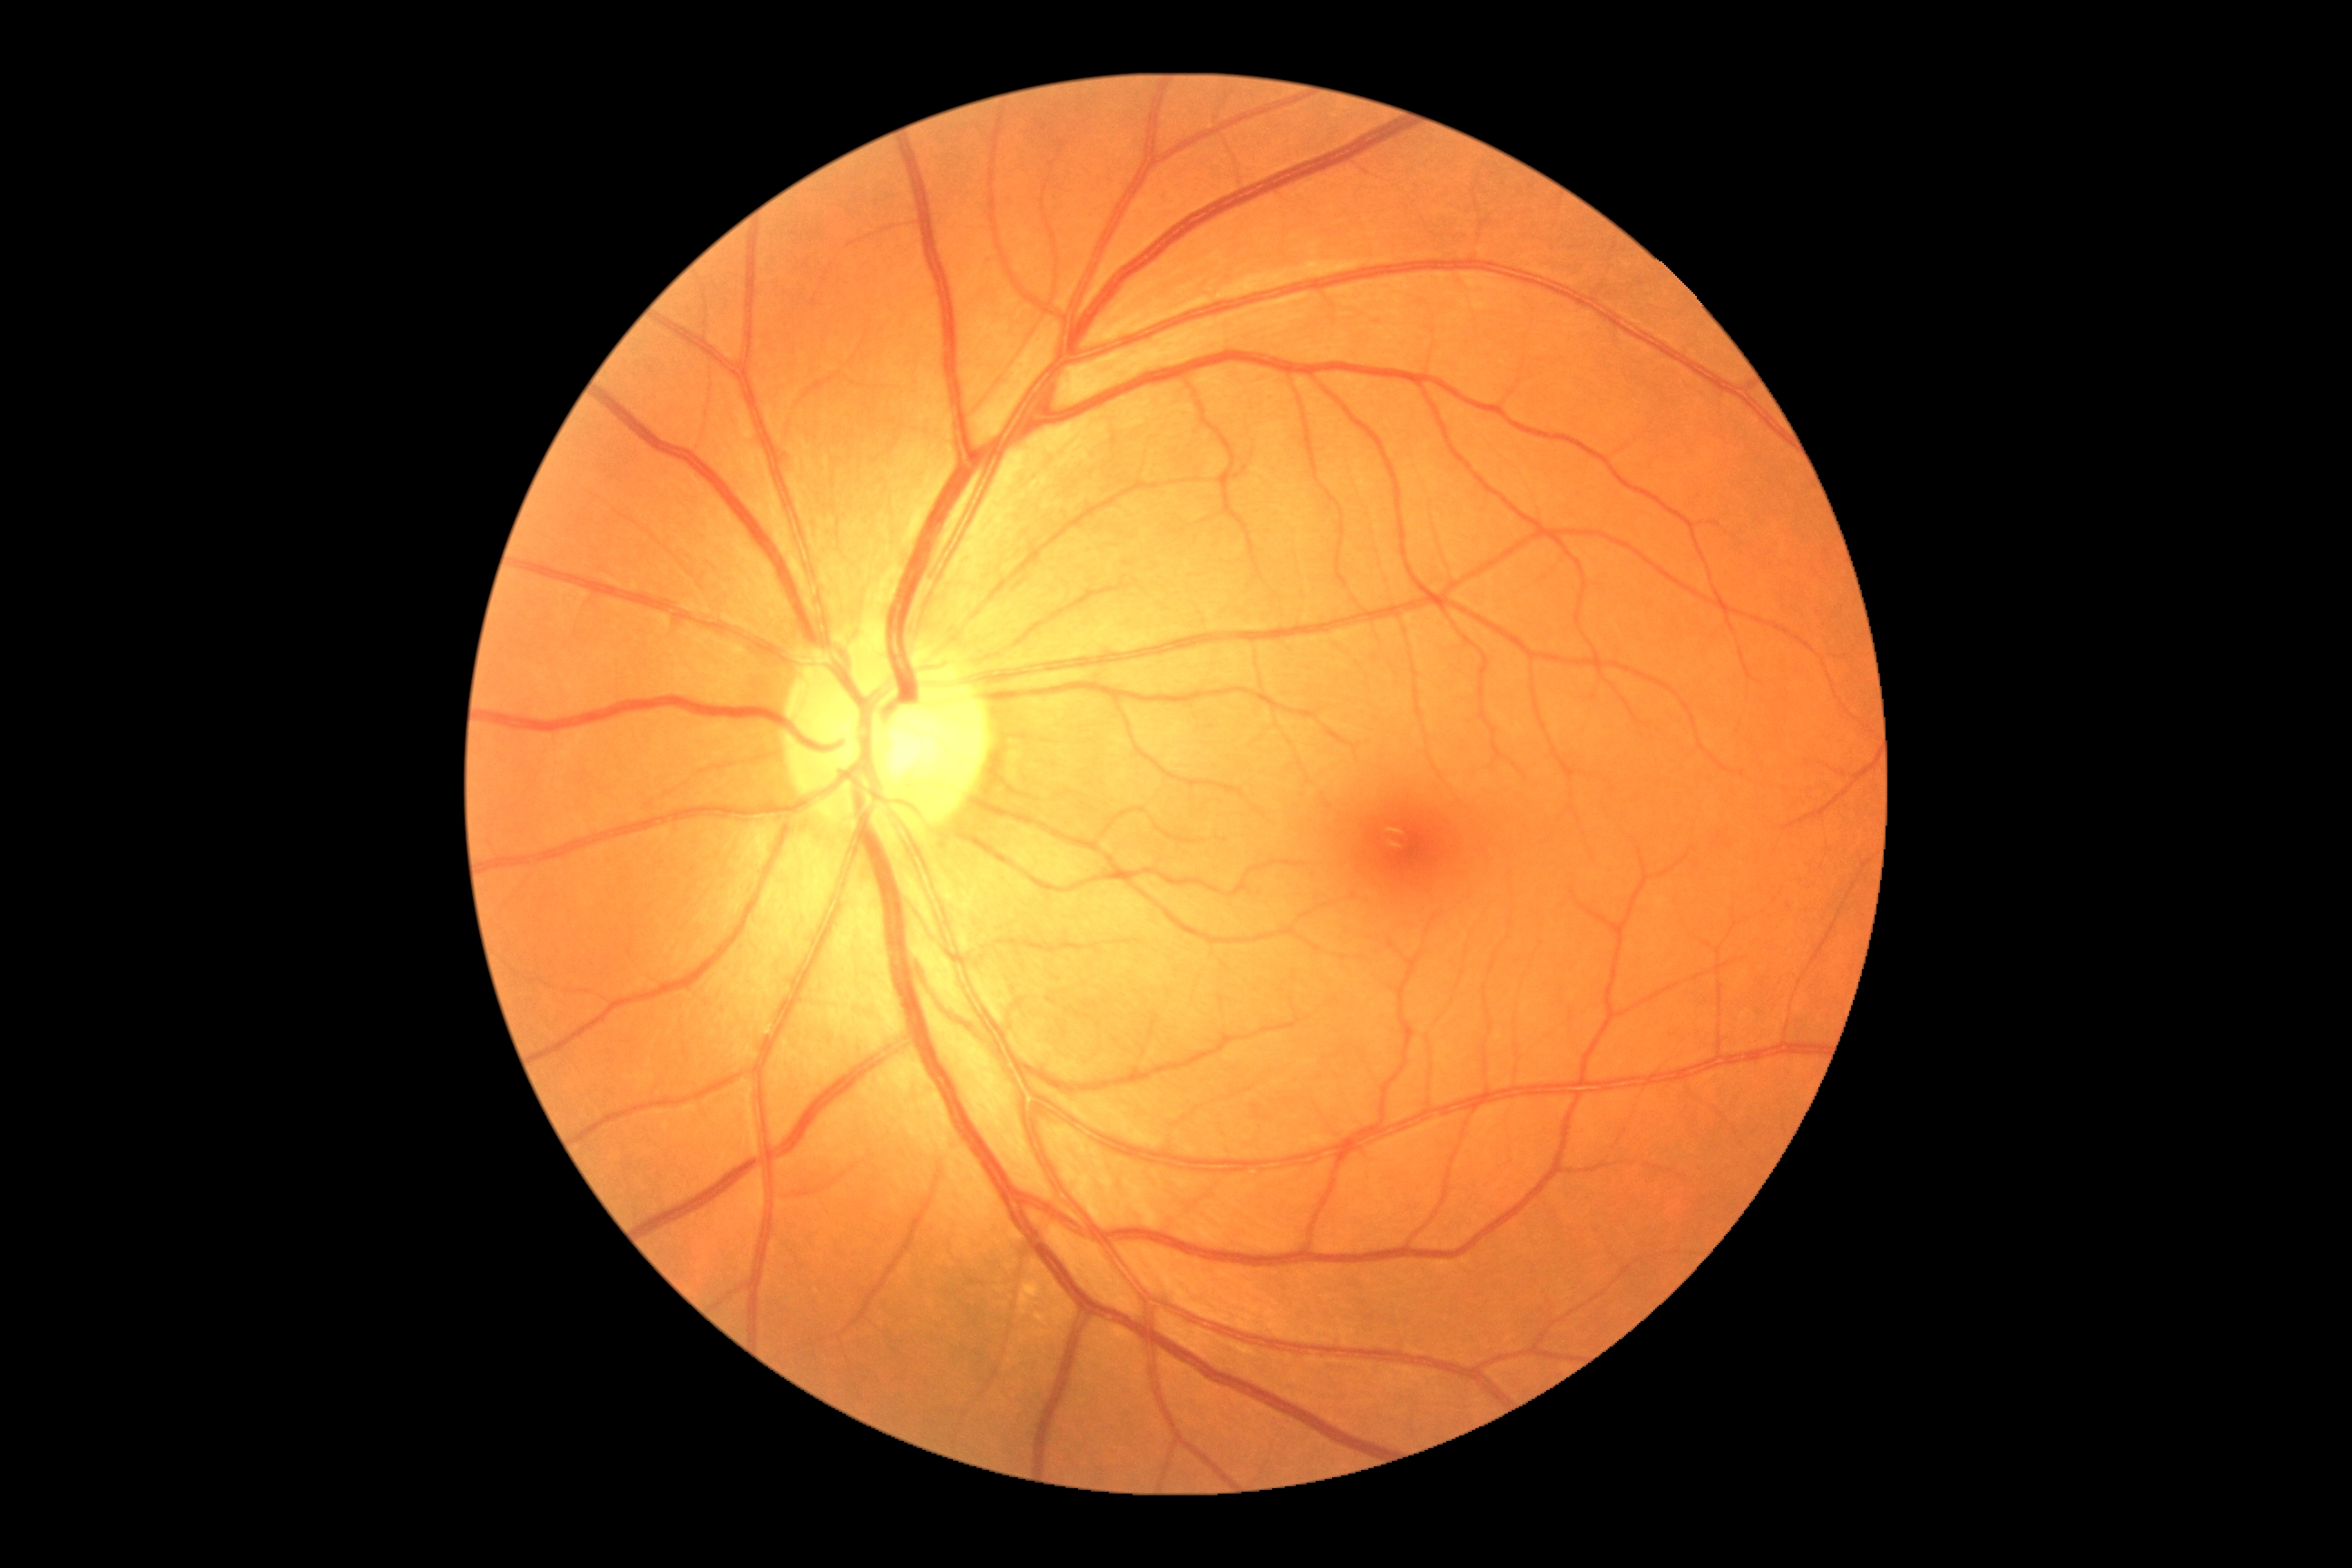 Diabetic retinopathy (DR) is no apparent retinopathy (grade 0). No signs of diabetic retinopathy.